45-degree field of view, CFP, DR severity per modified Davis staging
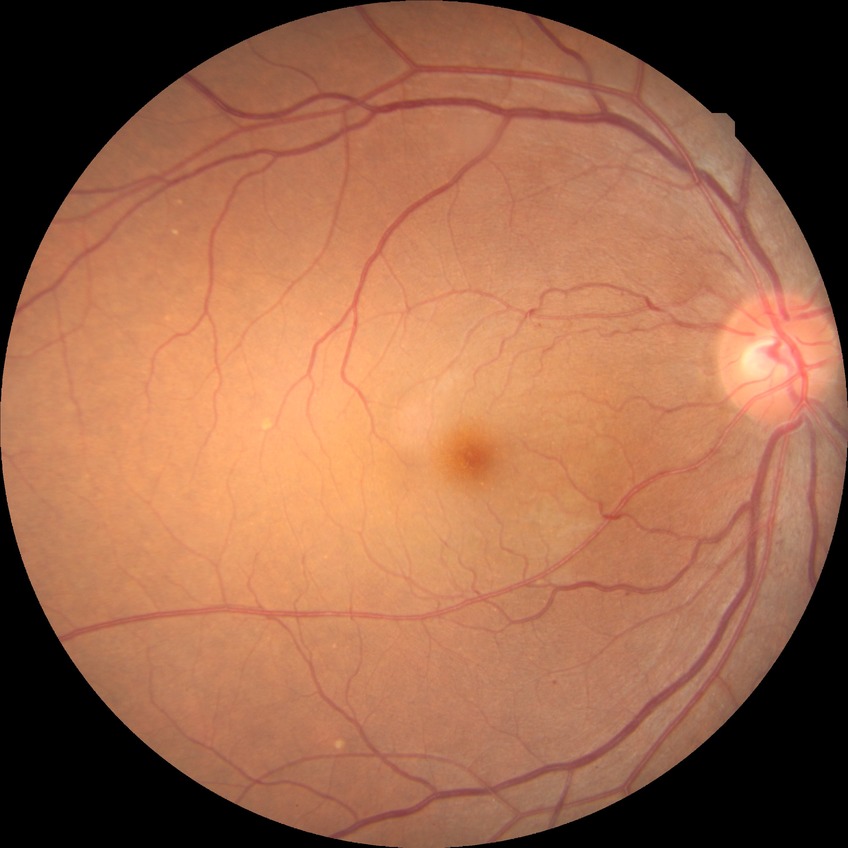   davis_grade: simple diabetic retinopathy (SDR)